Image size 848x848. Retinal fundus photograph. 45 degree fundus photograph. NIDEK AFC-230 fundus camera. Nonmydriatic — 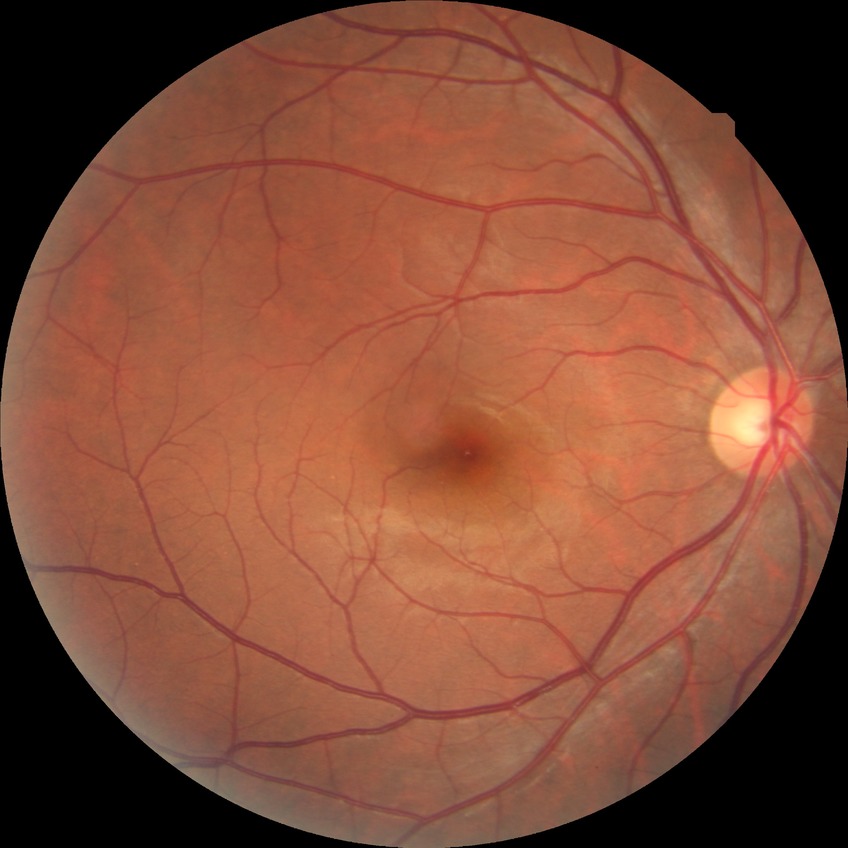

Assessment:
* Davis grade — NDR